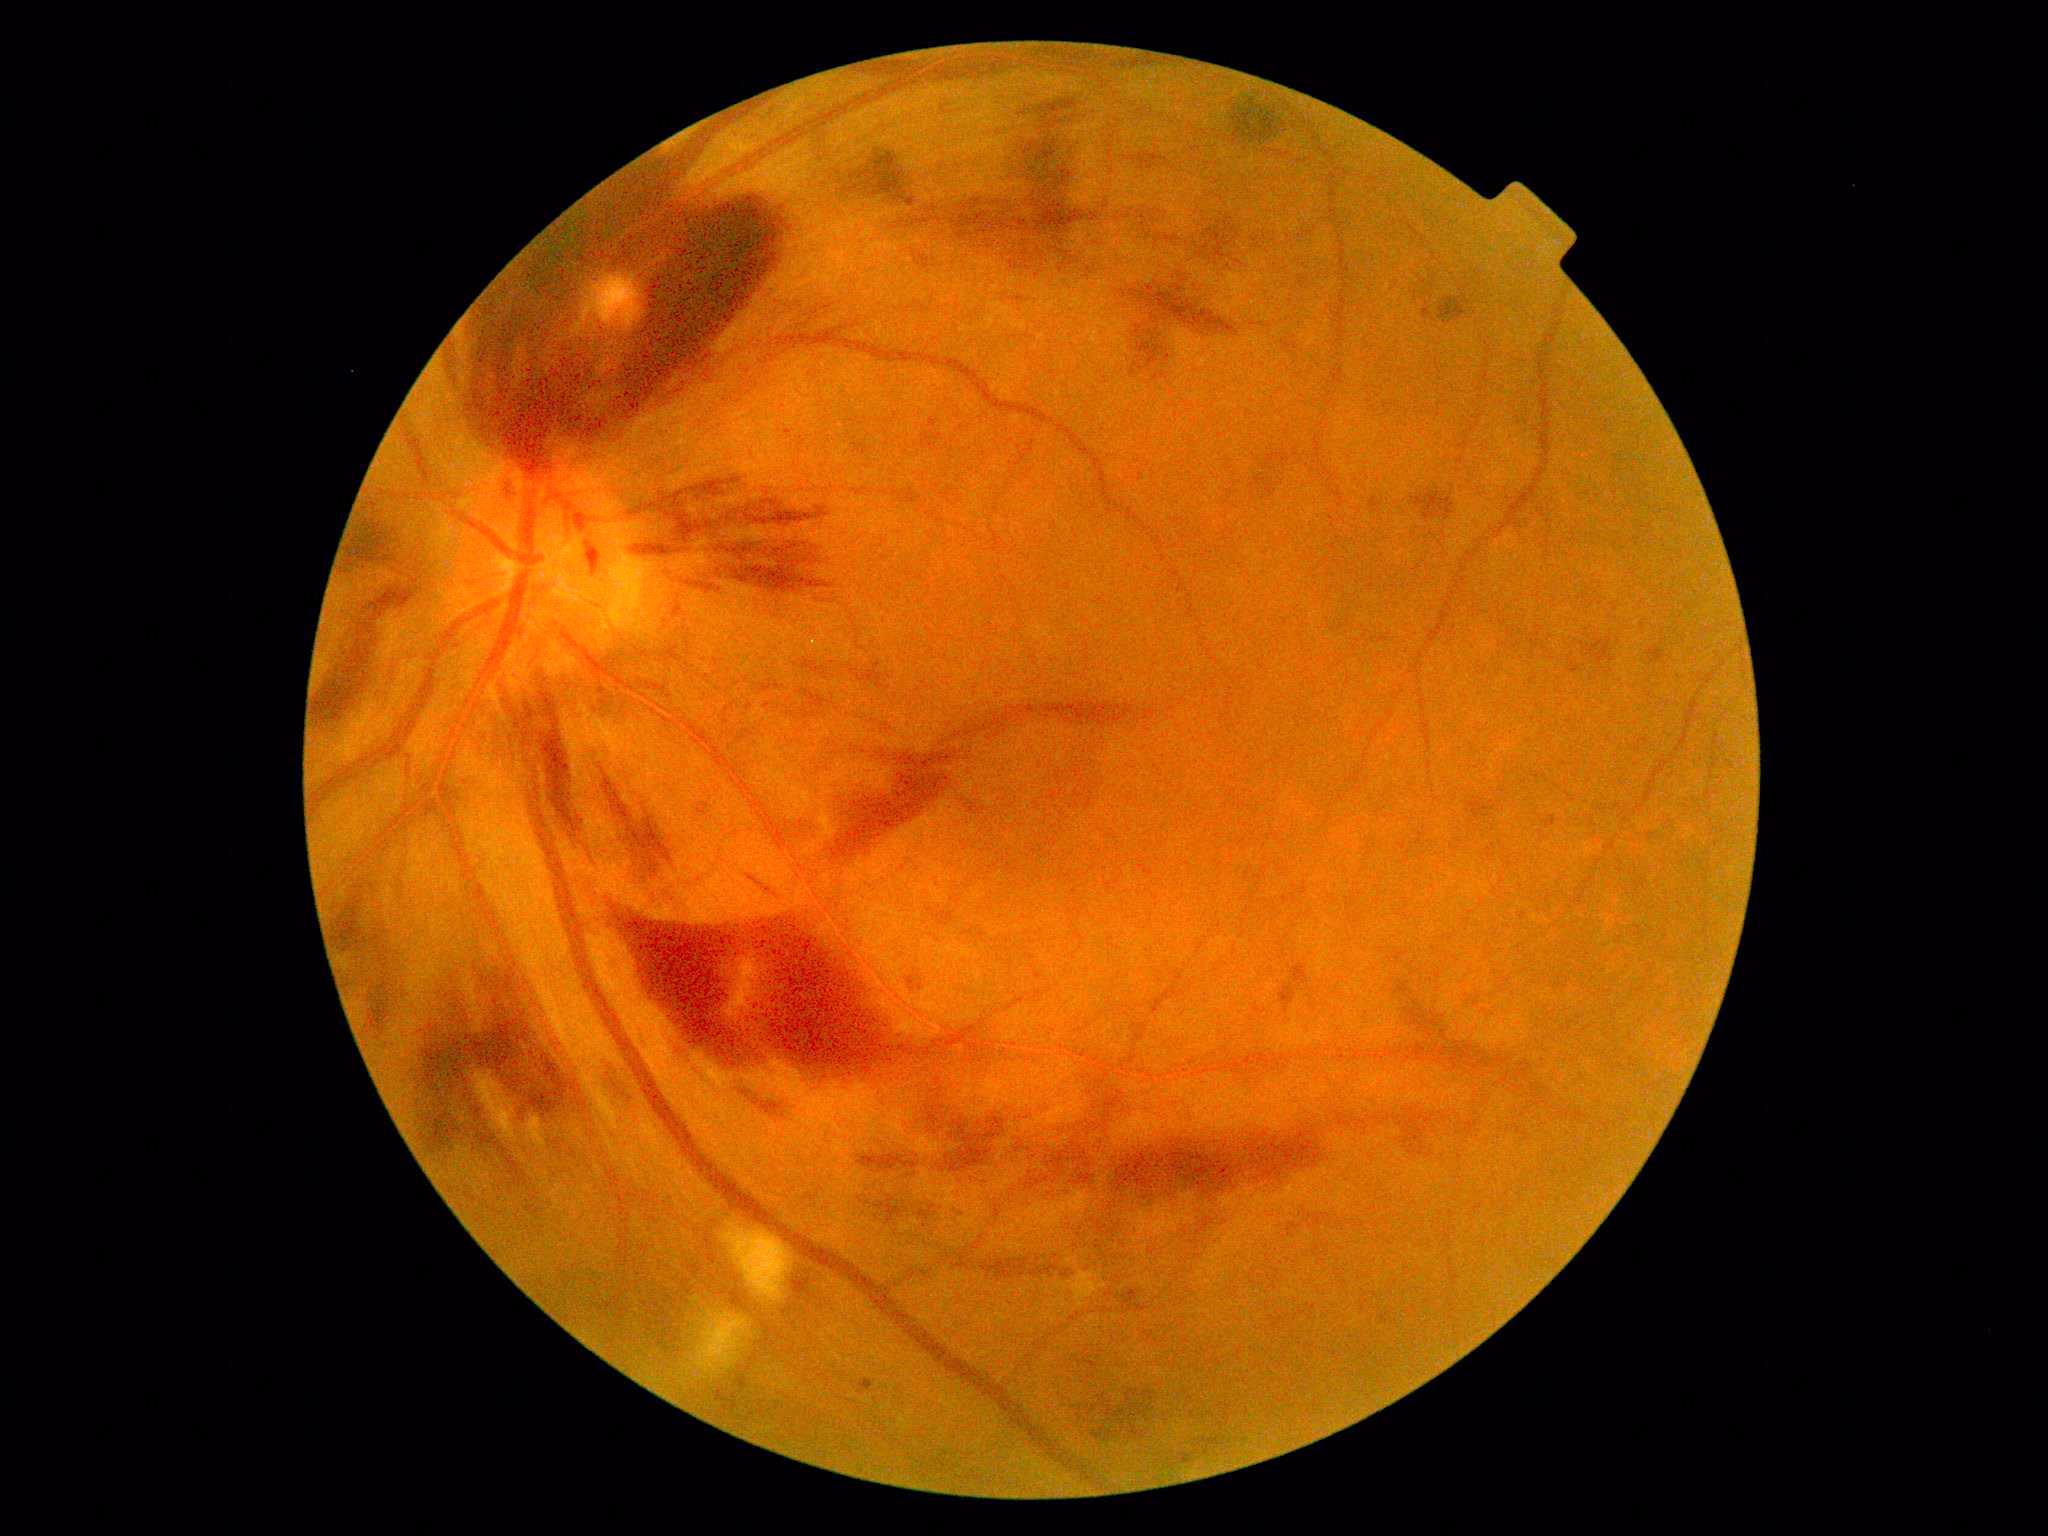

Disease class: proliferative diabetic retinopathy.
Diabetic retinopathy severity is PDR (grade 4).